FOV: 45 degrees
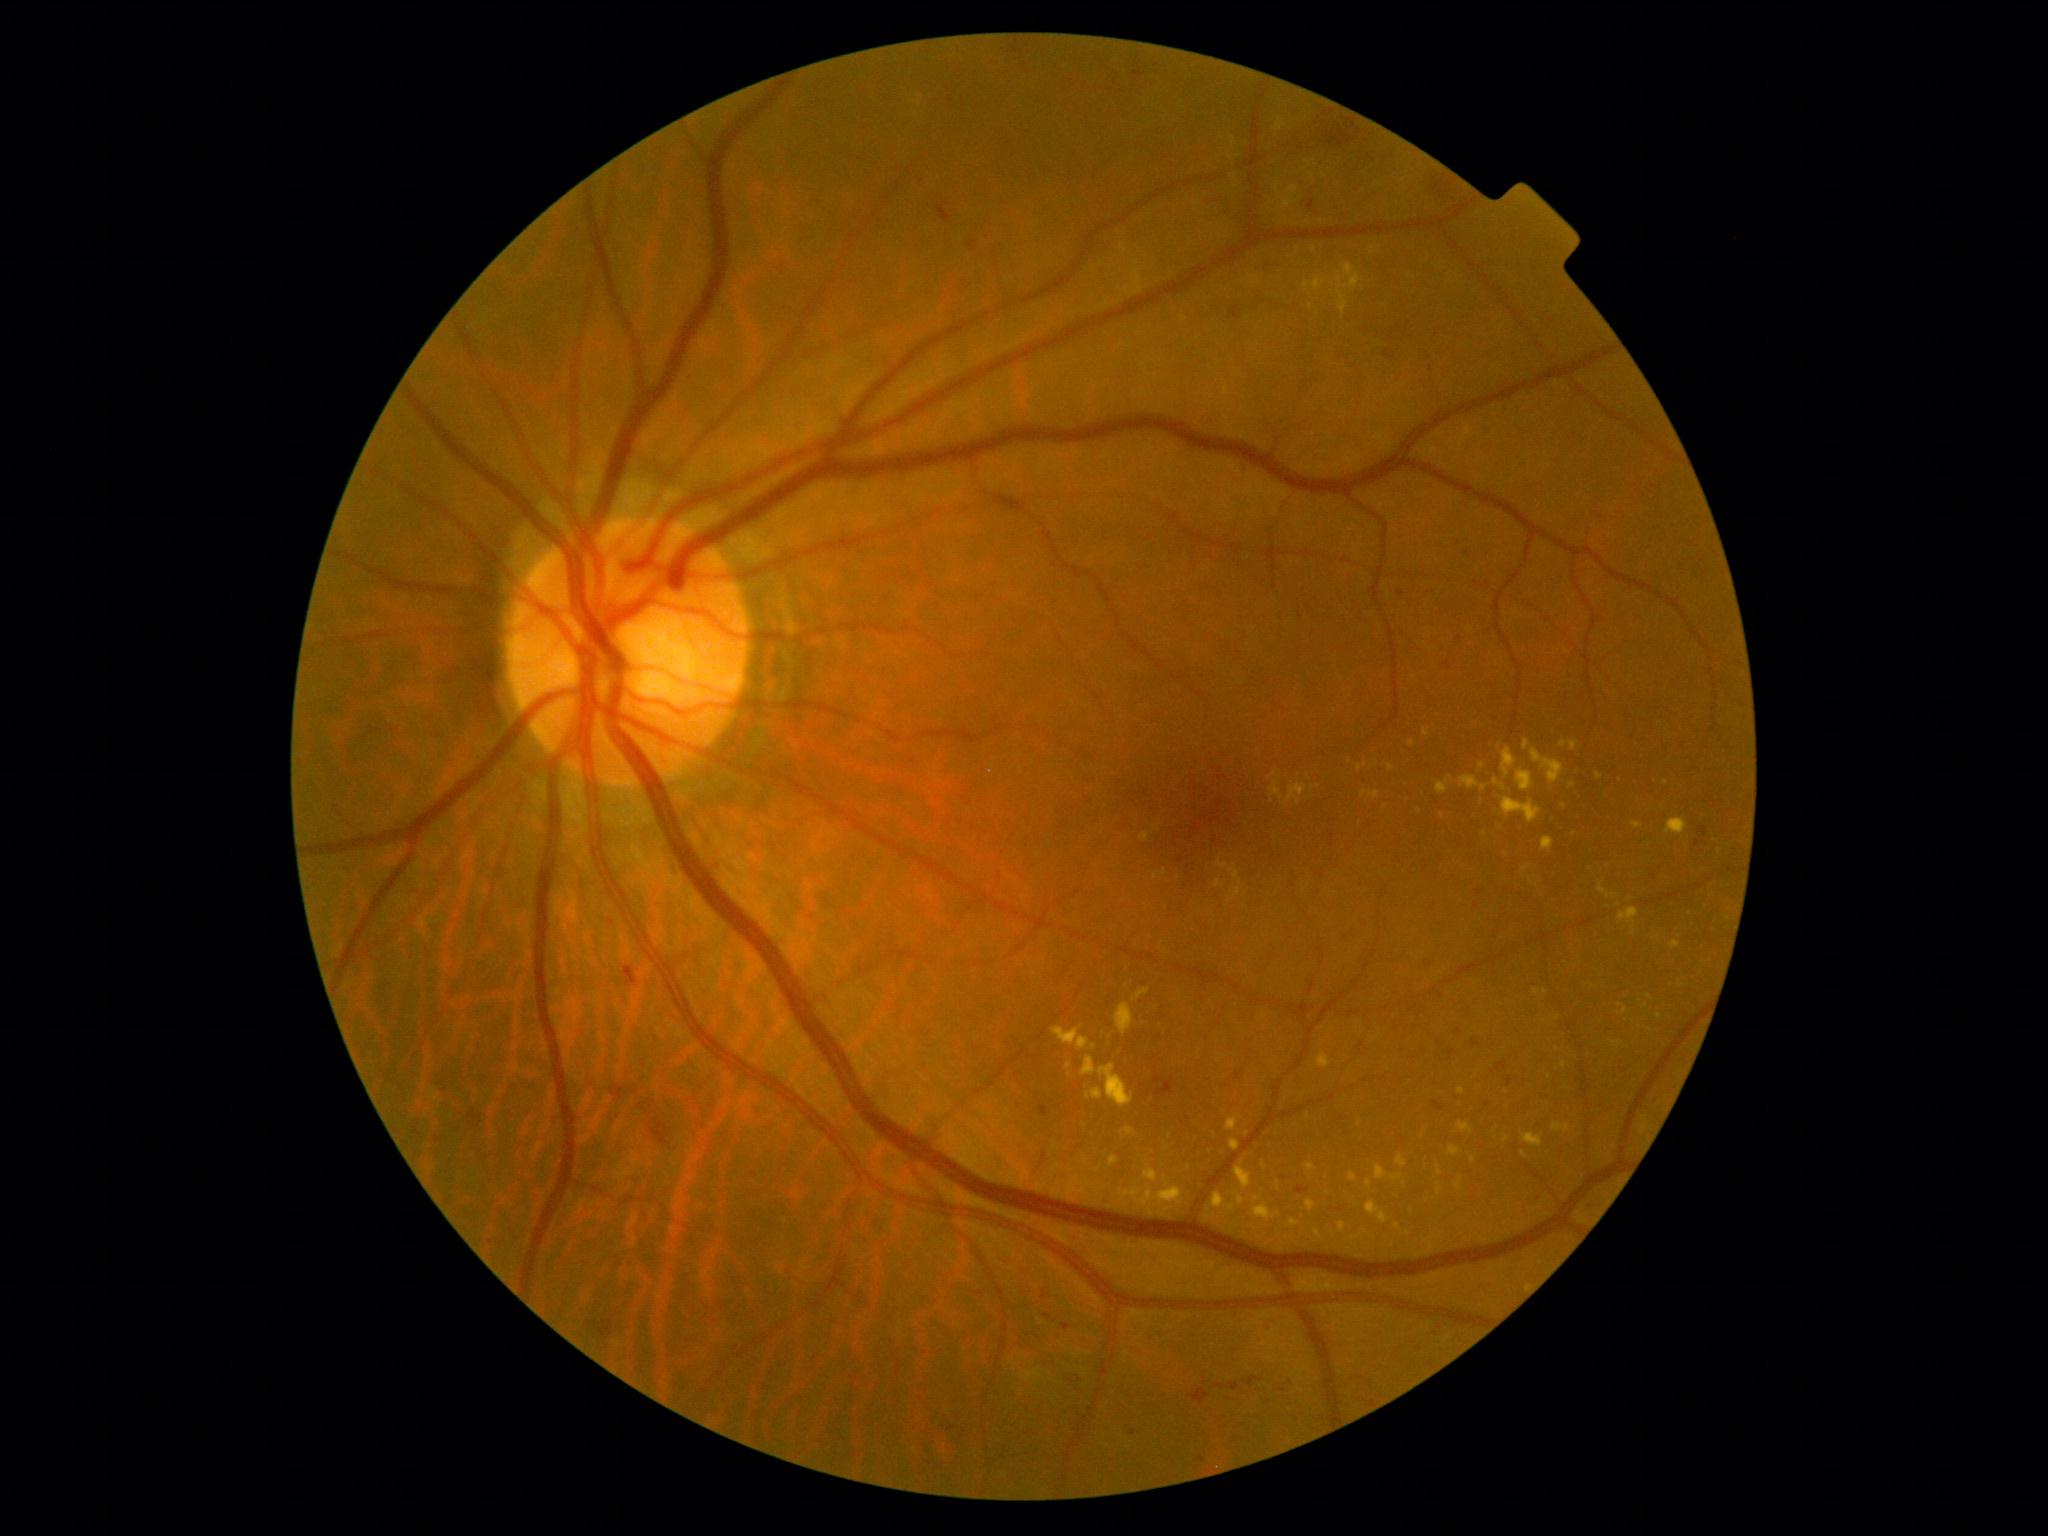
{"partial": true, "dr_grade": 2, "lesions": {"ex": [[1081, 1057, 1096, 1077], [1456, 1178, 1463, 1191], [1437, 1166, 1442, 1176], [1228, 888, 1242, 902], [1235, 1162, 1254, 1192], [1350, 1173, 1357, 1182], [1394, 1224, 1403, 1232], [1516, 769, 1533, 792], [1618, 1004, 1628, 1016], [1133, 988, 1150, 1001], [1305, 1201, 1317, 1212], [1376, 1166, 1387, 1181], [1269, 782, 1308, 809]], "ex_small": [[1537, 993], [1474, 1160], [1442, 816], [1360, 769], [1564, 807], [1484, 834]]}}